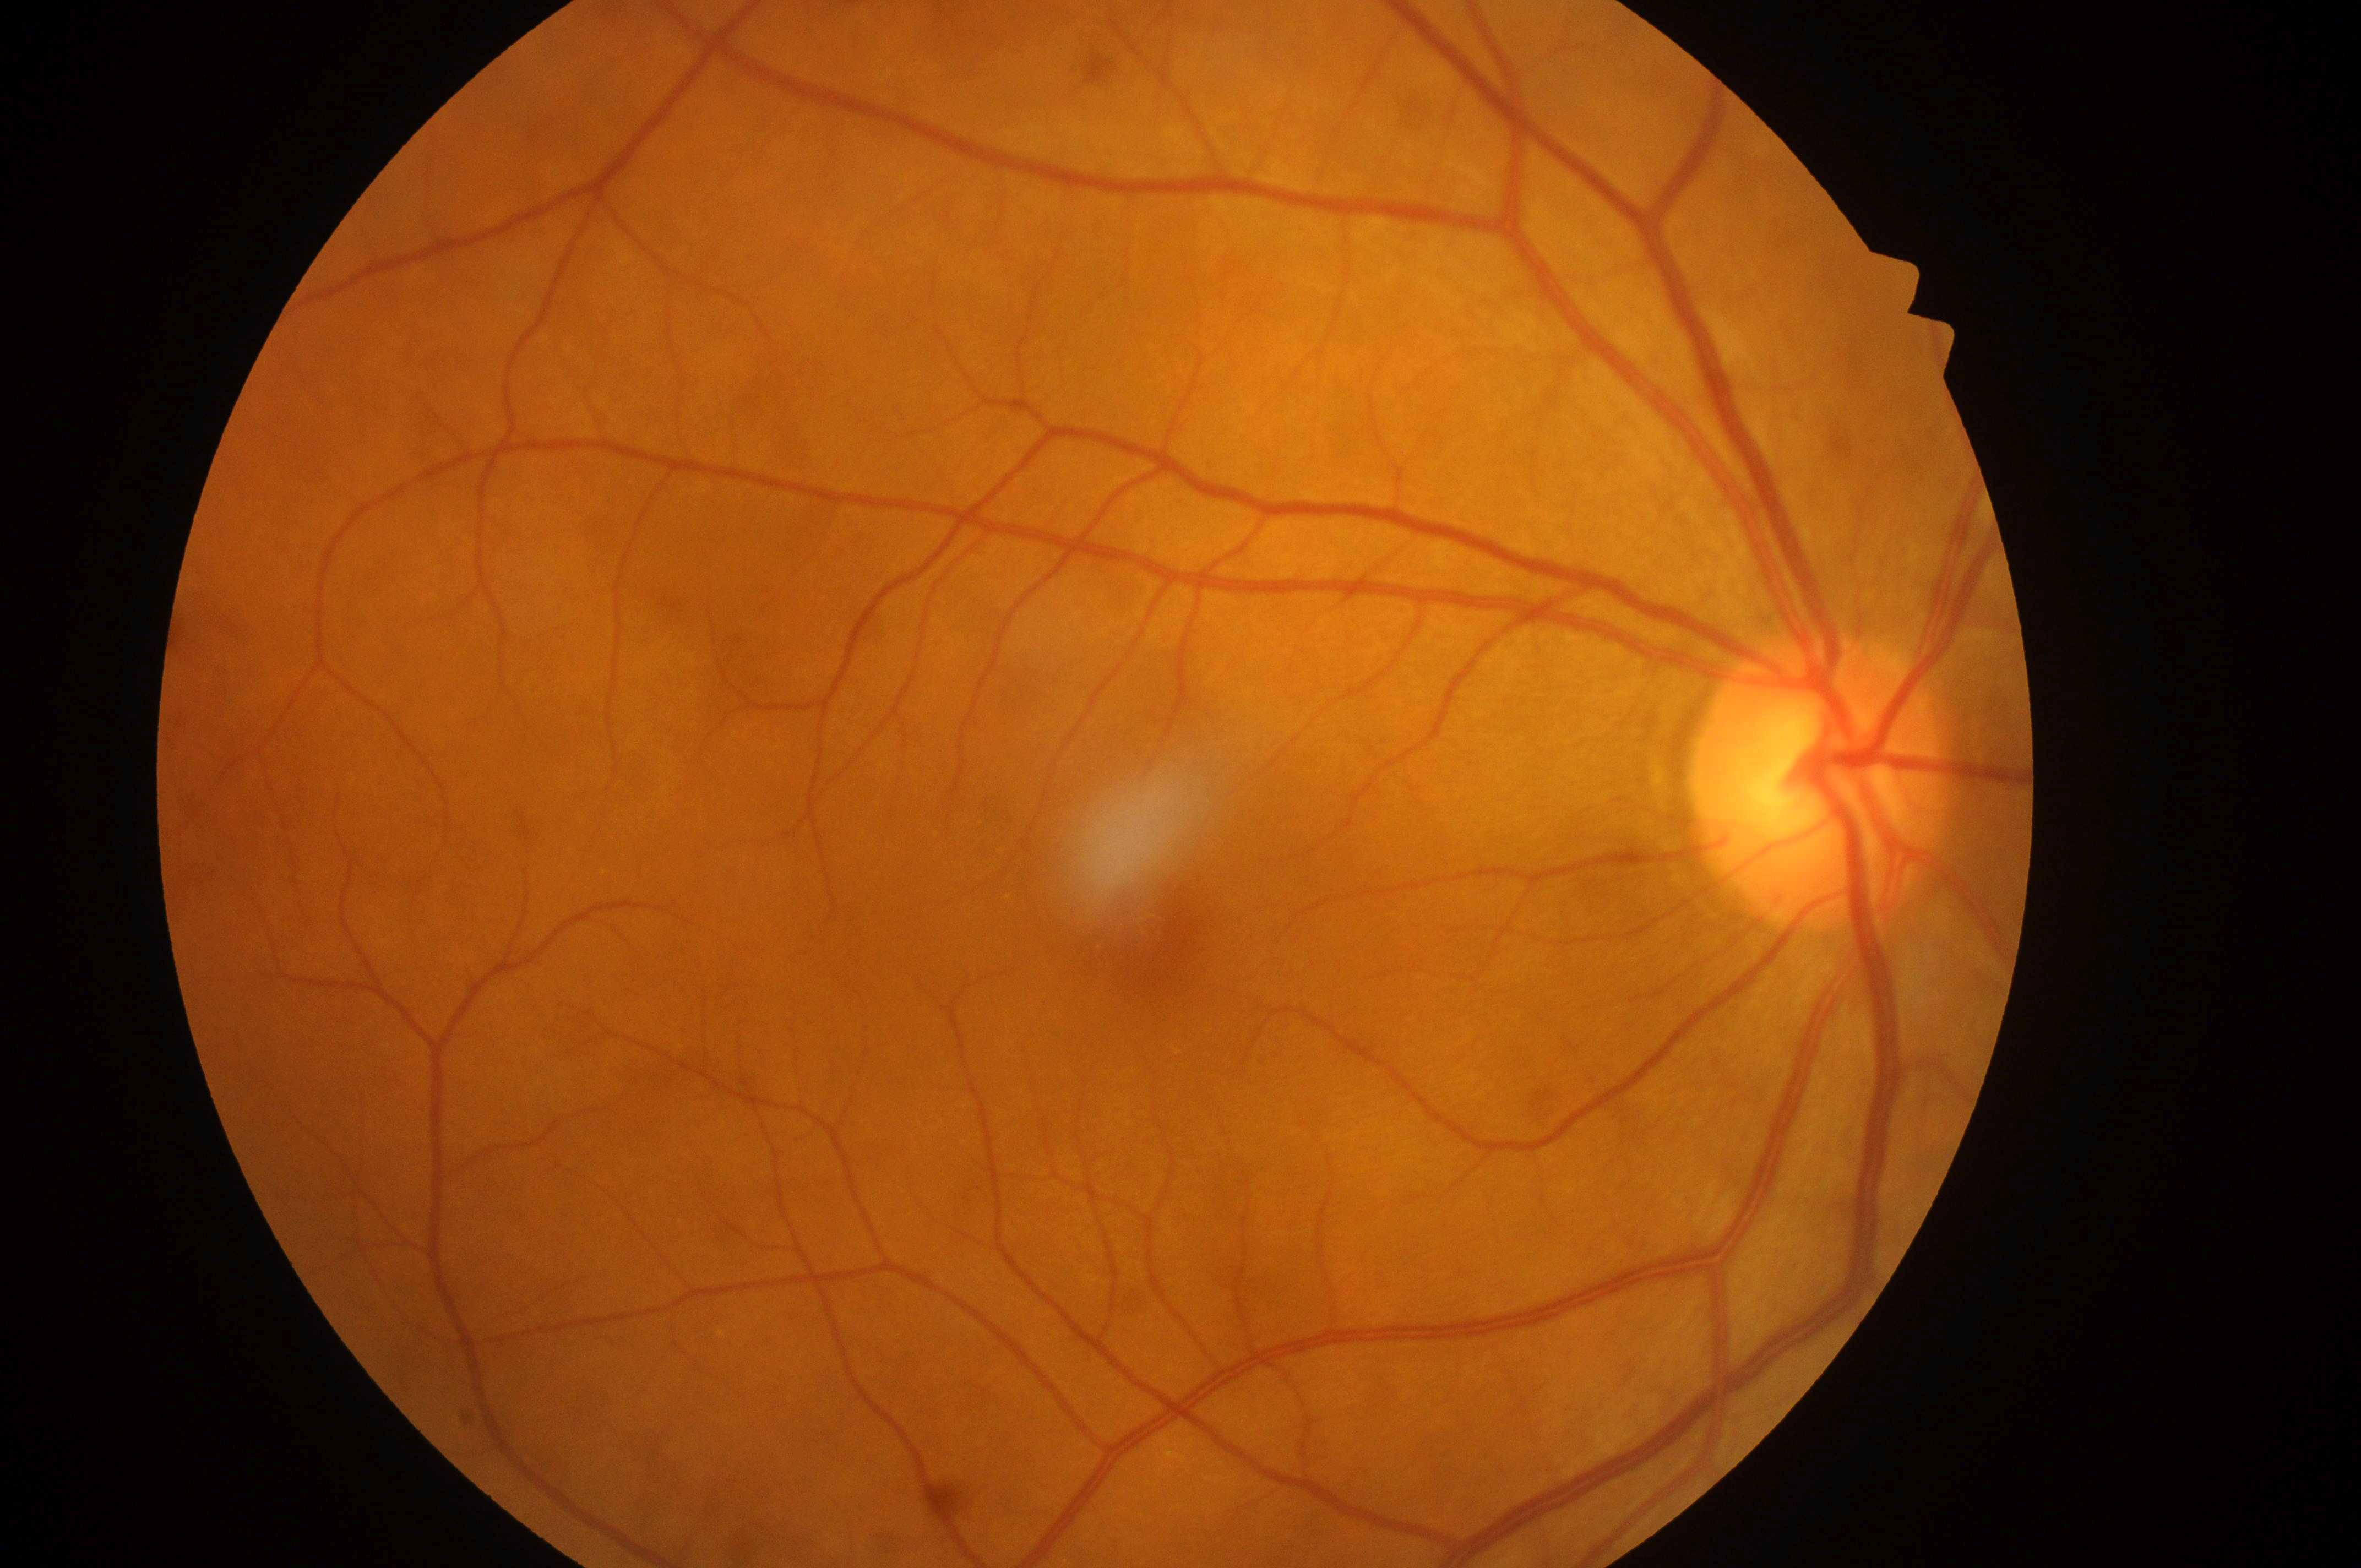

Disc center: (1818,792). DR stage: grade 0 (no apparent retinopathy) — no visible signs of diabetic retinopathy. Fovea center located at (1165,946). Imaged eye: right. DME risk: no risk (grade 0) — no apparent hard exudates.